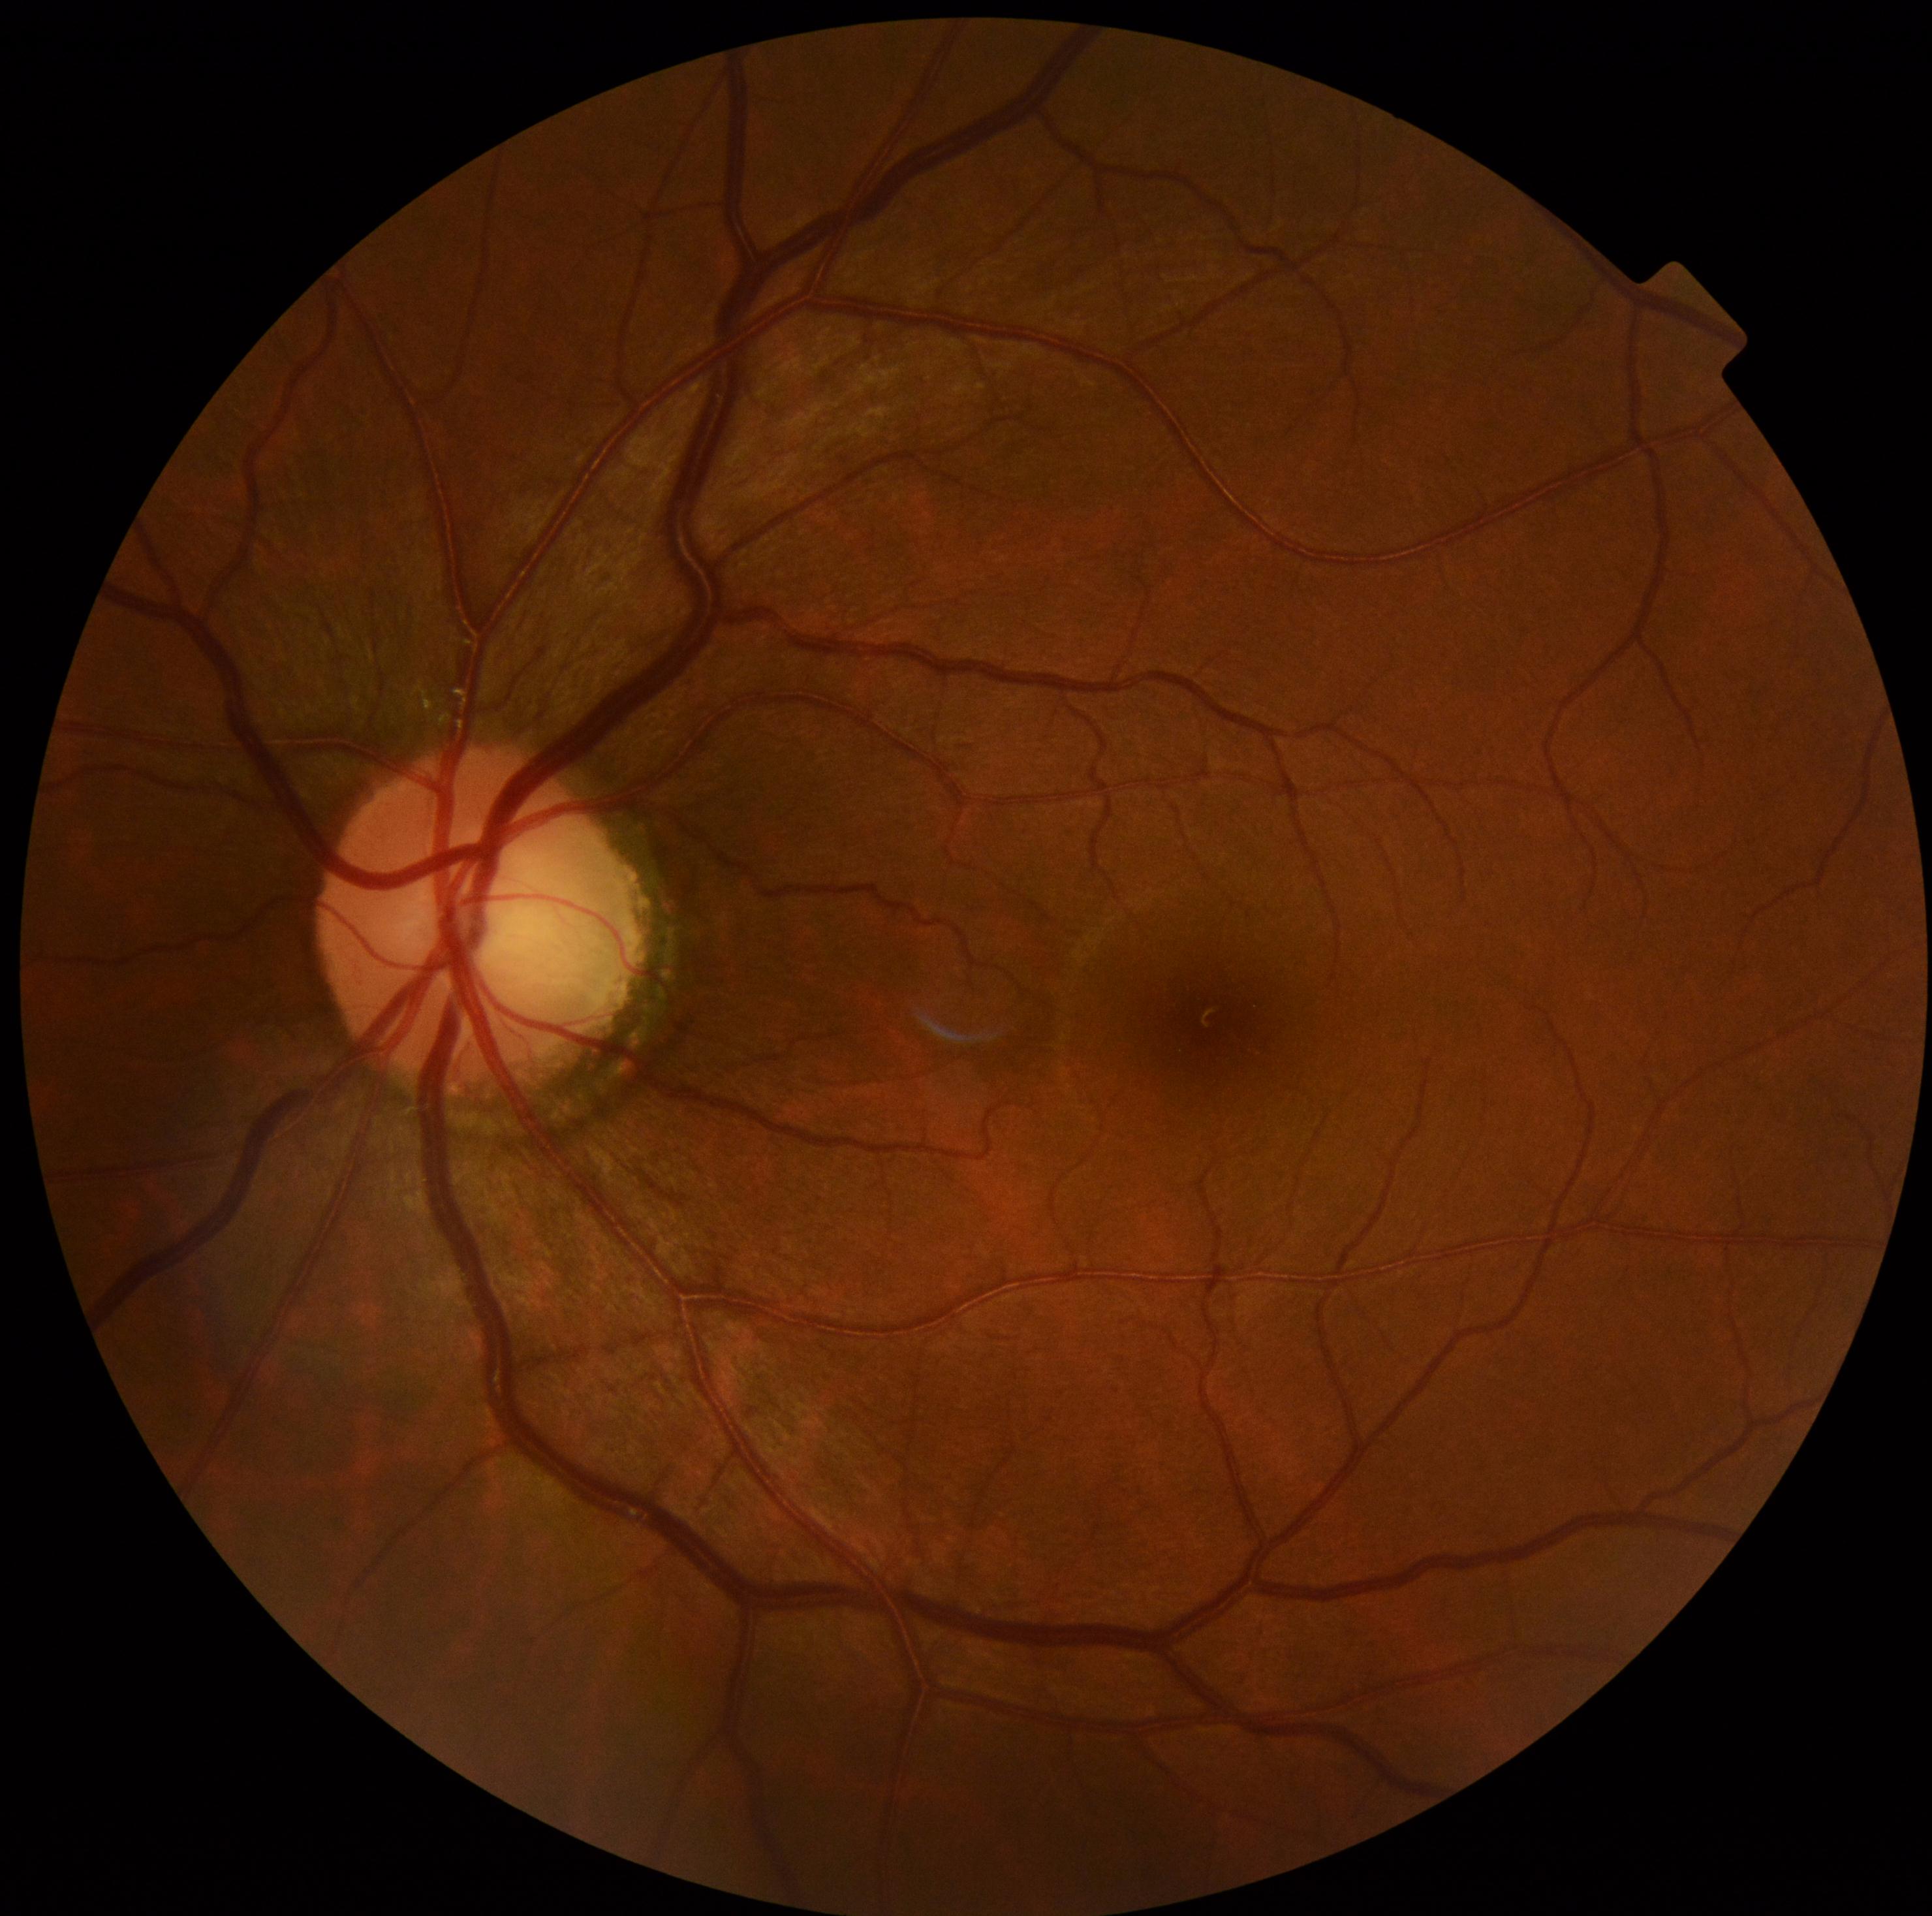
{
  "dr_grade": "grade 0"
}